Color fundus photograph · 2089x1764px: 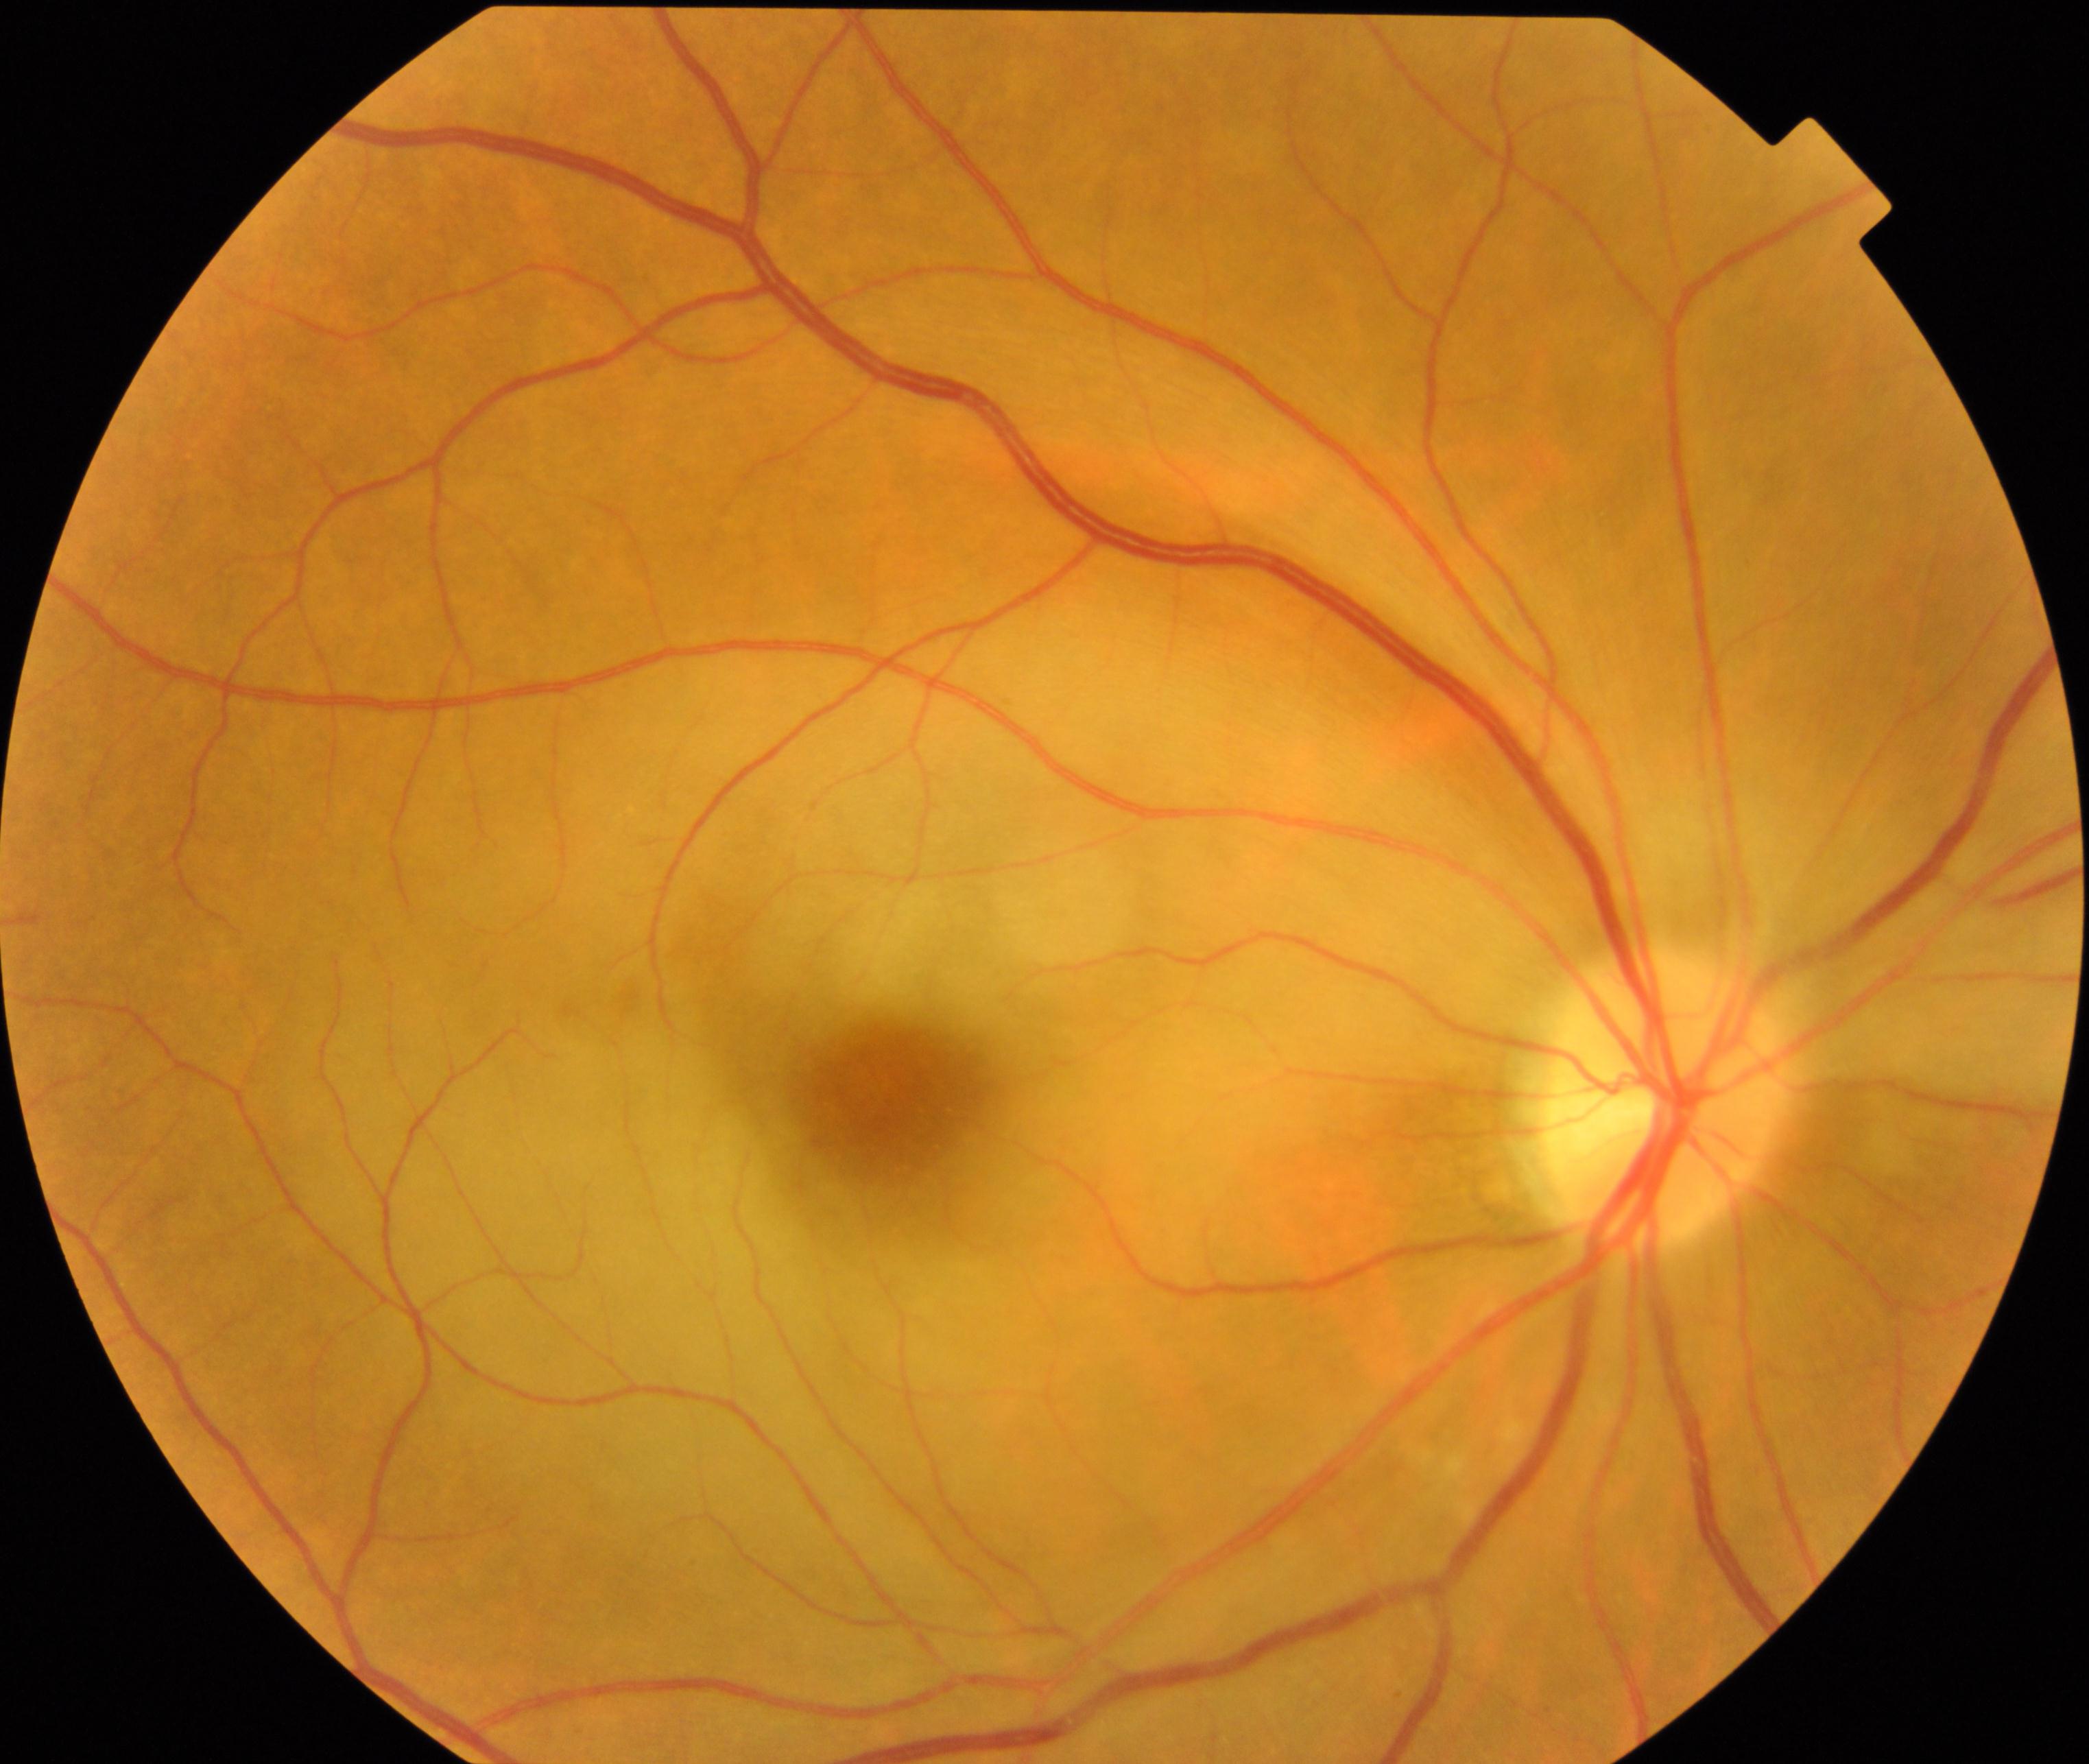 Impression: RAO (retinal artery occlusion).